No pharmacologic dilation, color fundus image:
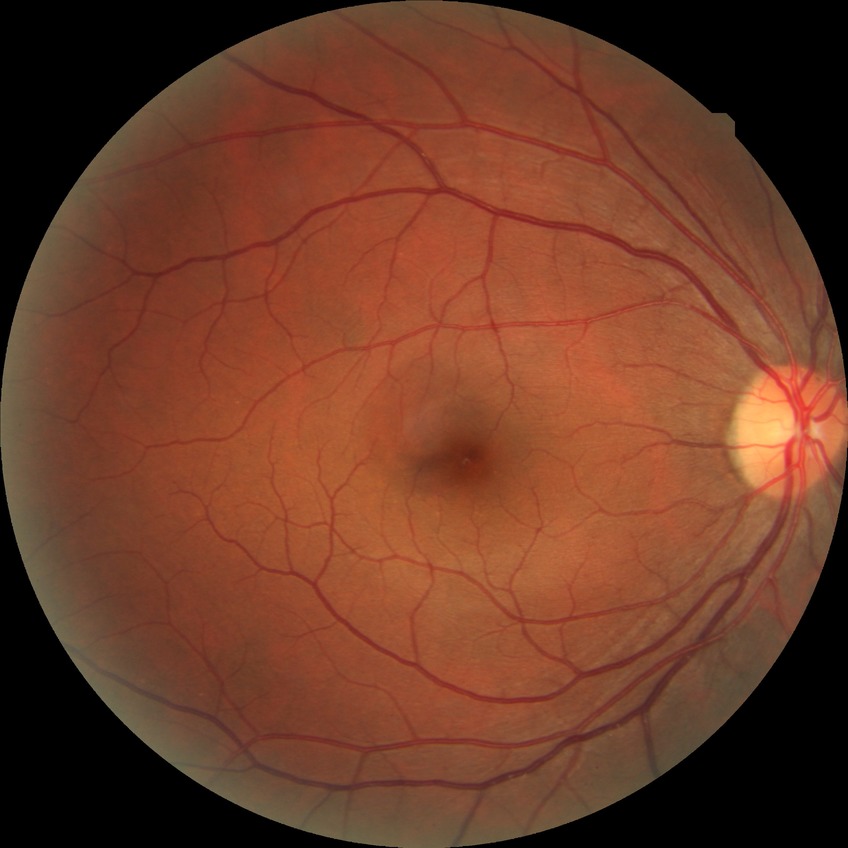 diabetic retinopathy (DR): NDR (no diabetic retinopathy)